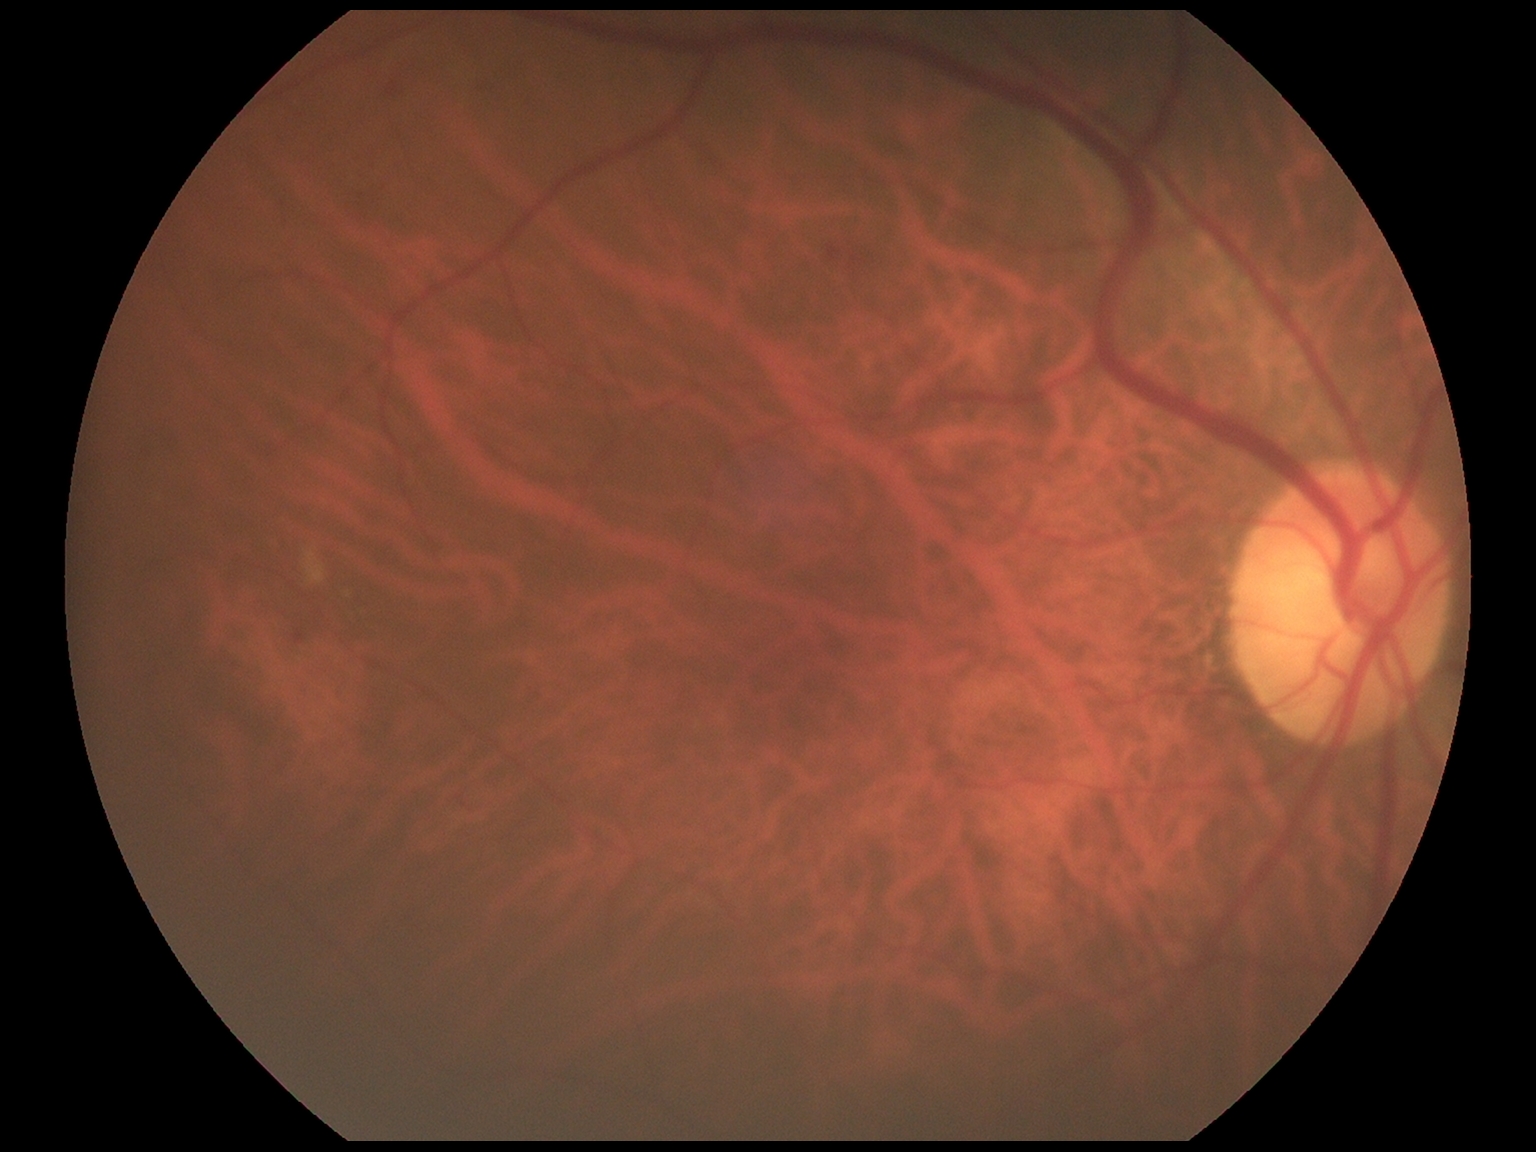 Findings:
- DR stage: moderate non-proliferative diabetic retinopathy (grade 2)